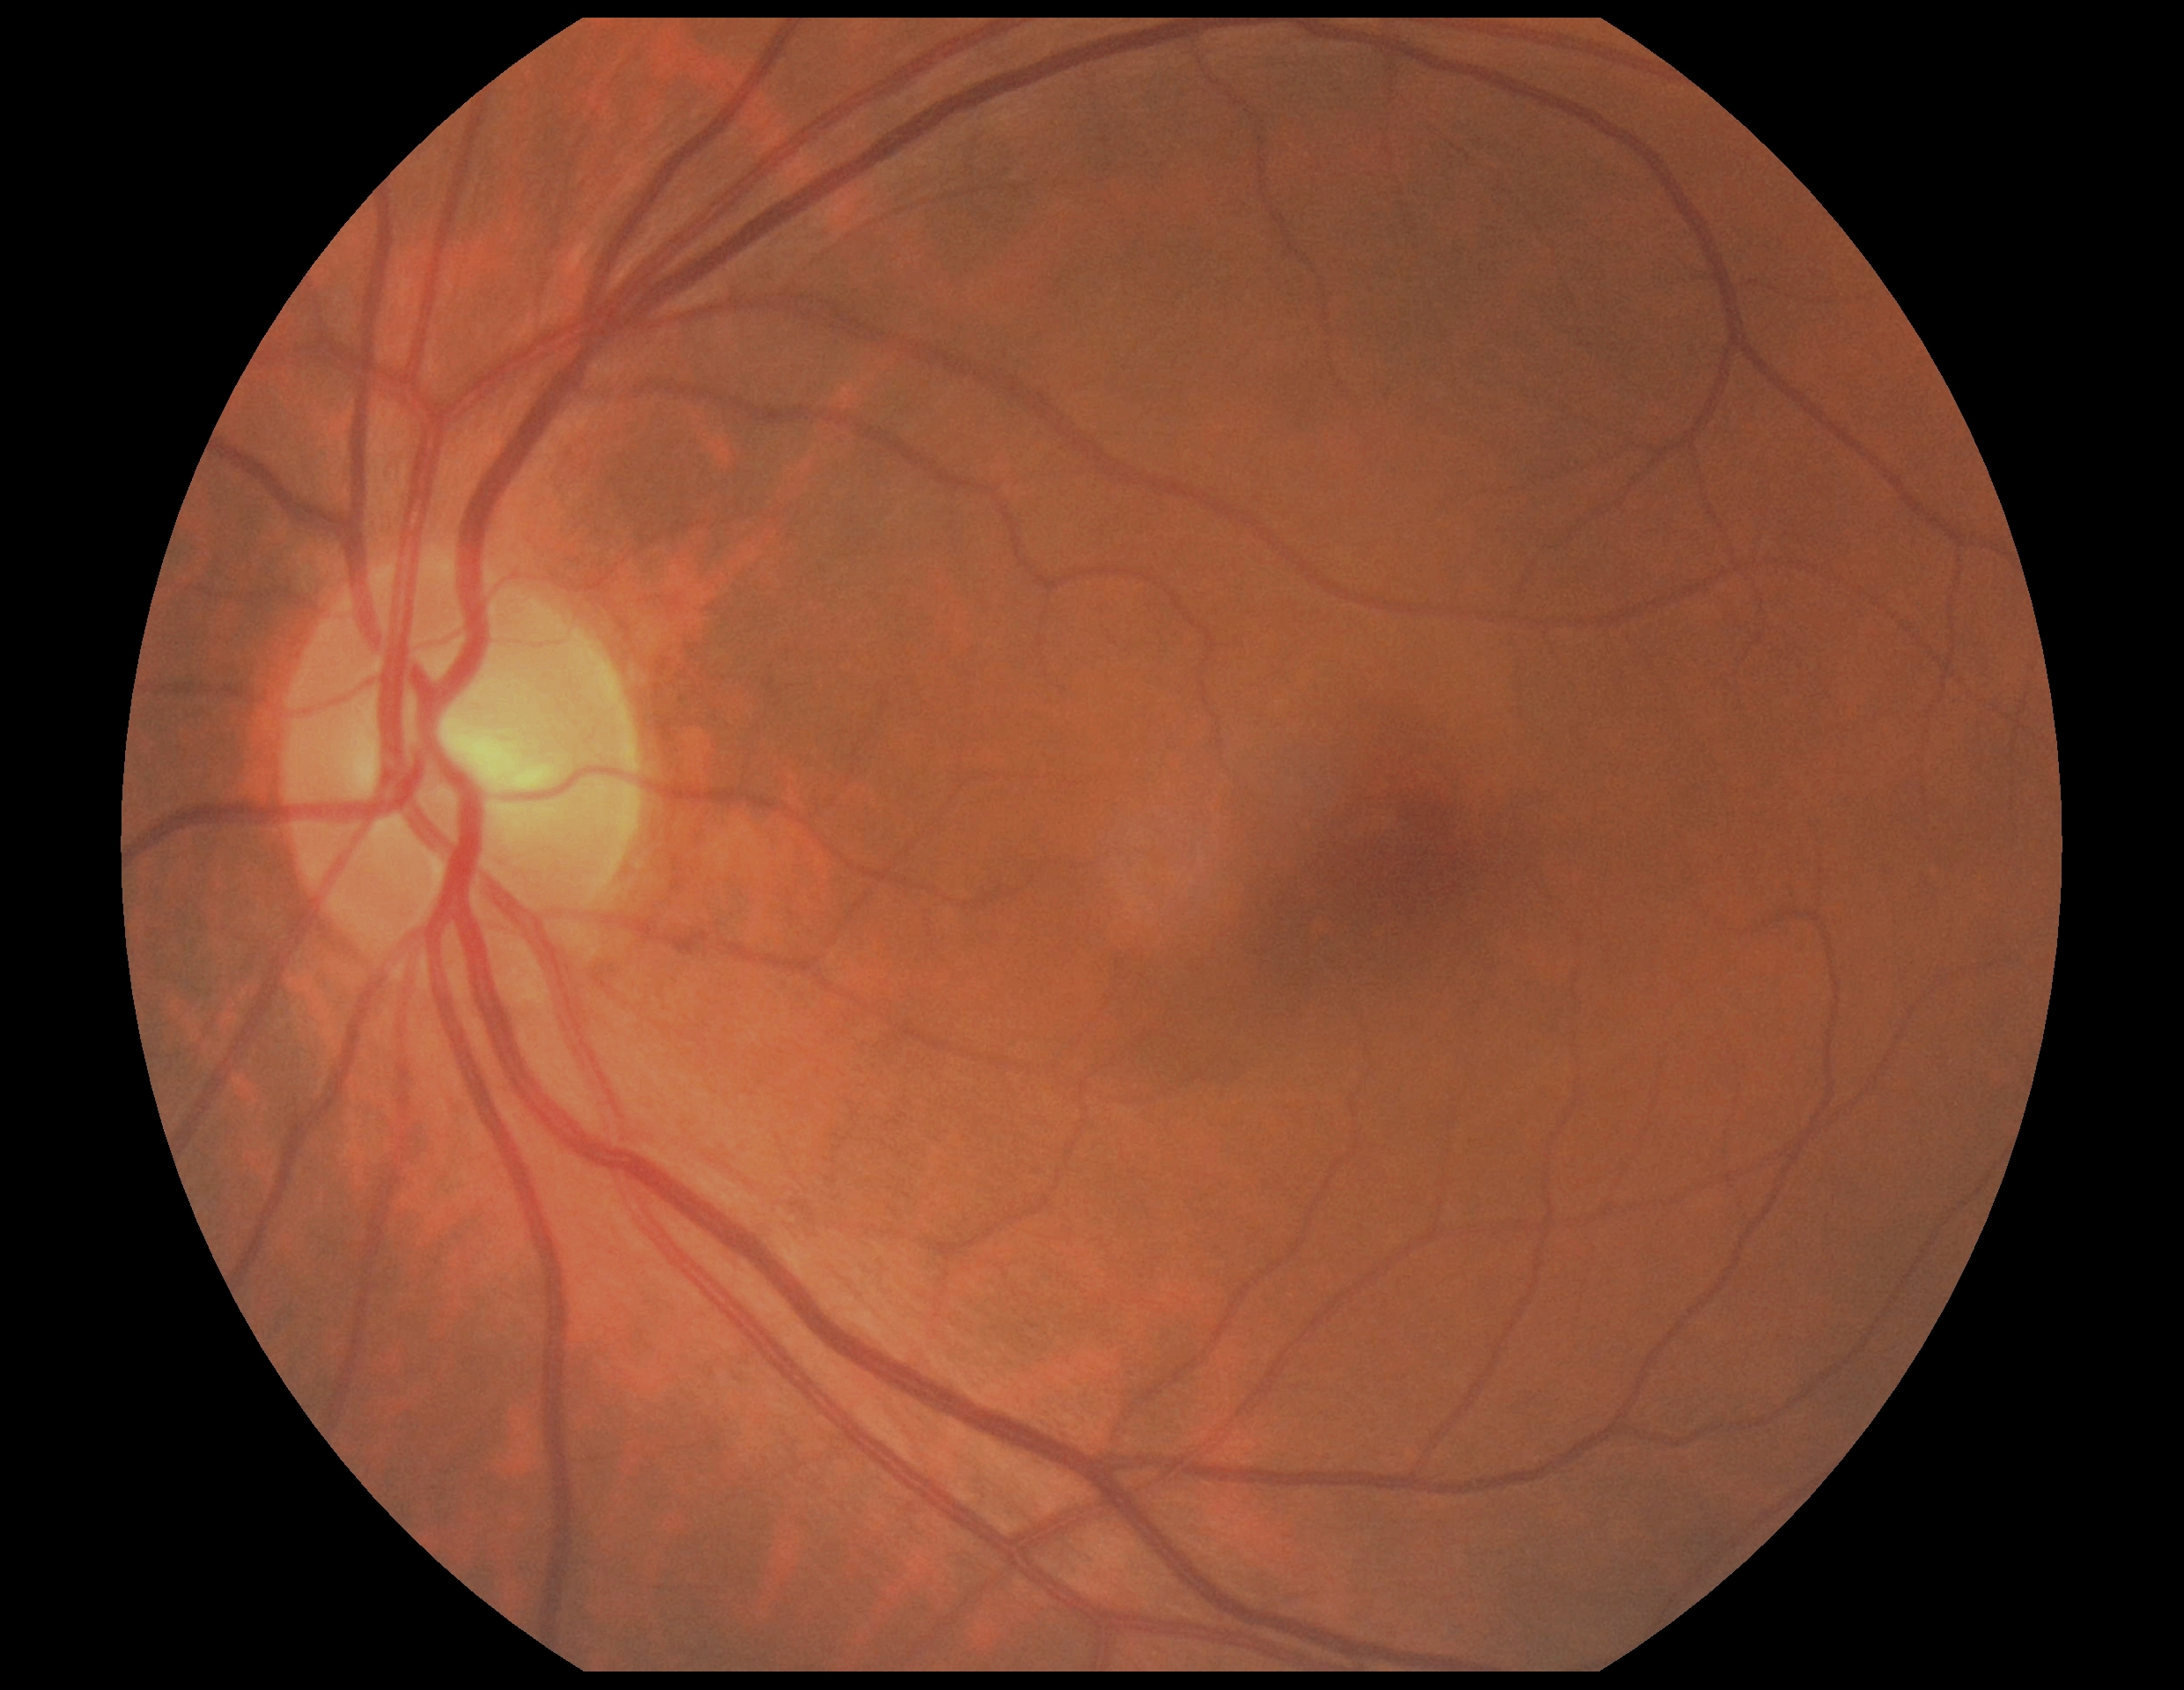
DR severity@0/4 — no visible signs of diabetic retinopathy; DR impression@negative for DR.